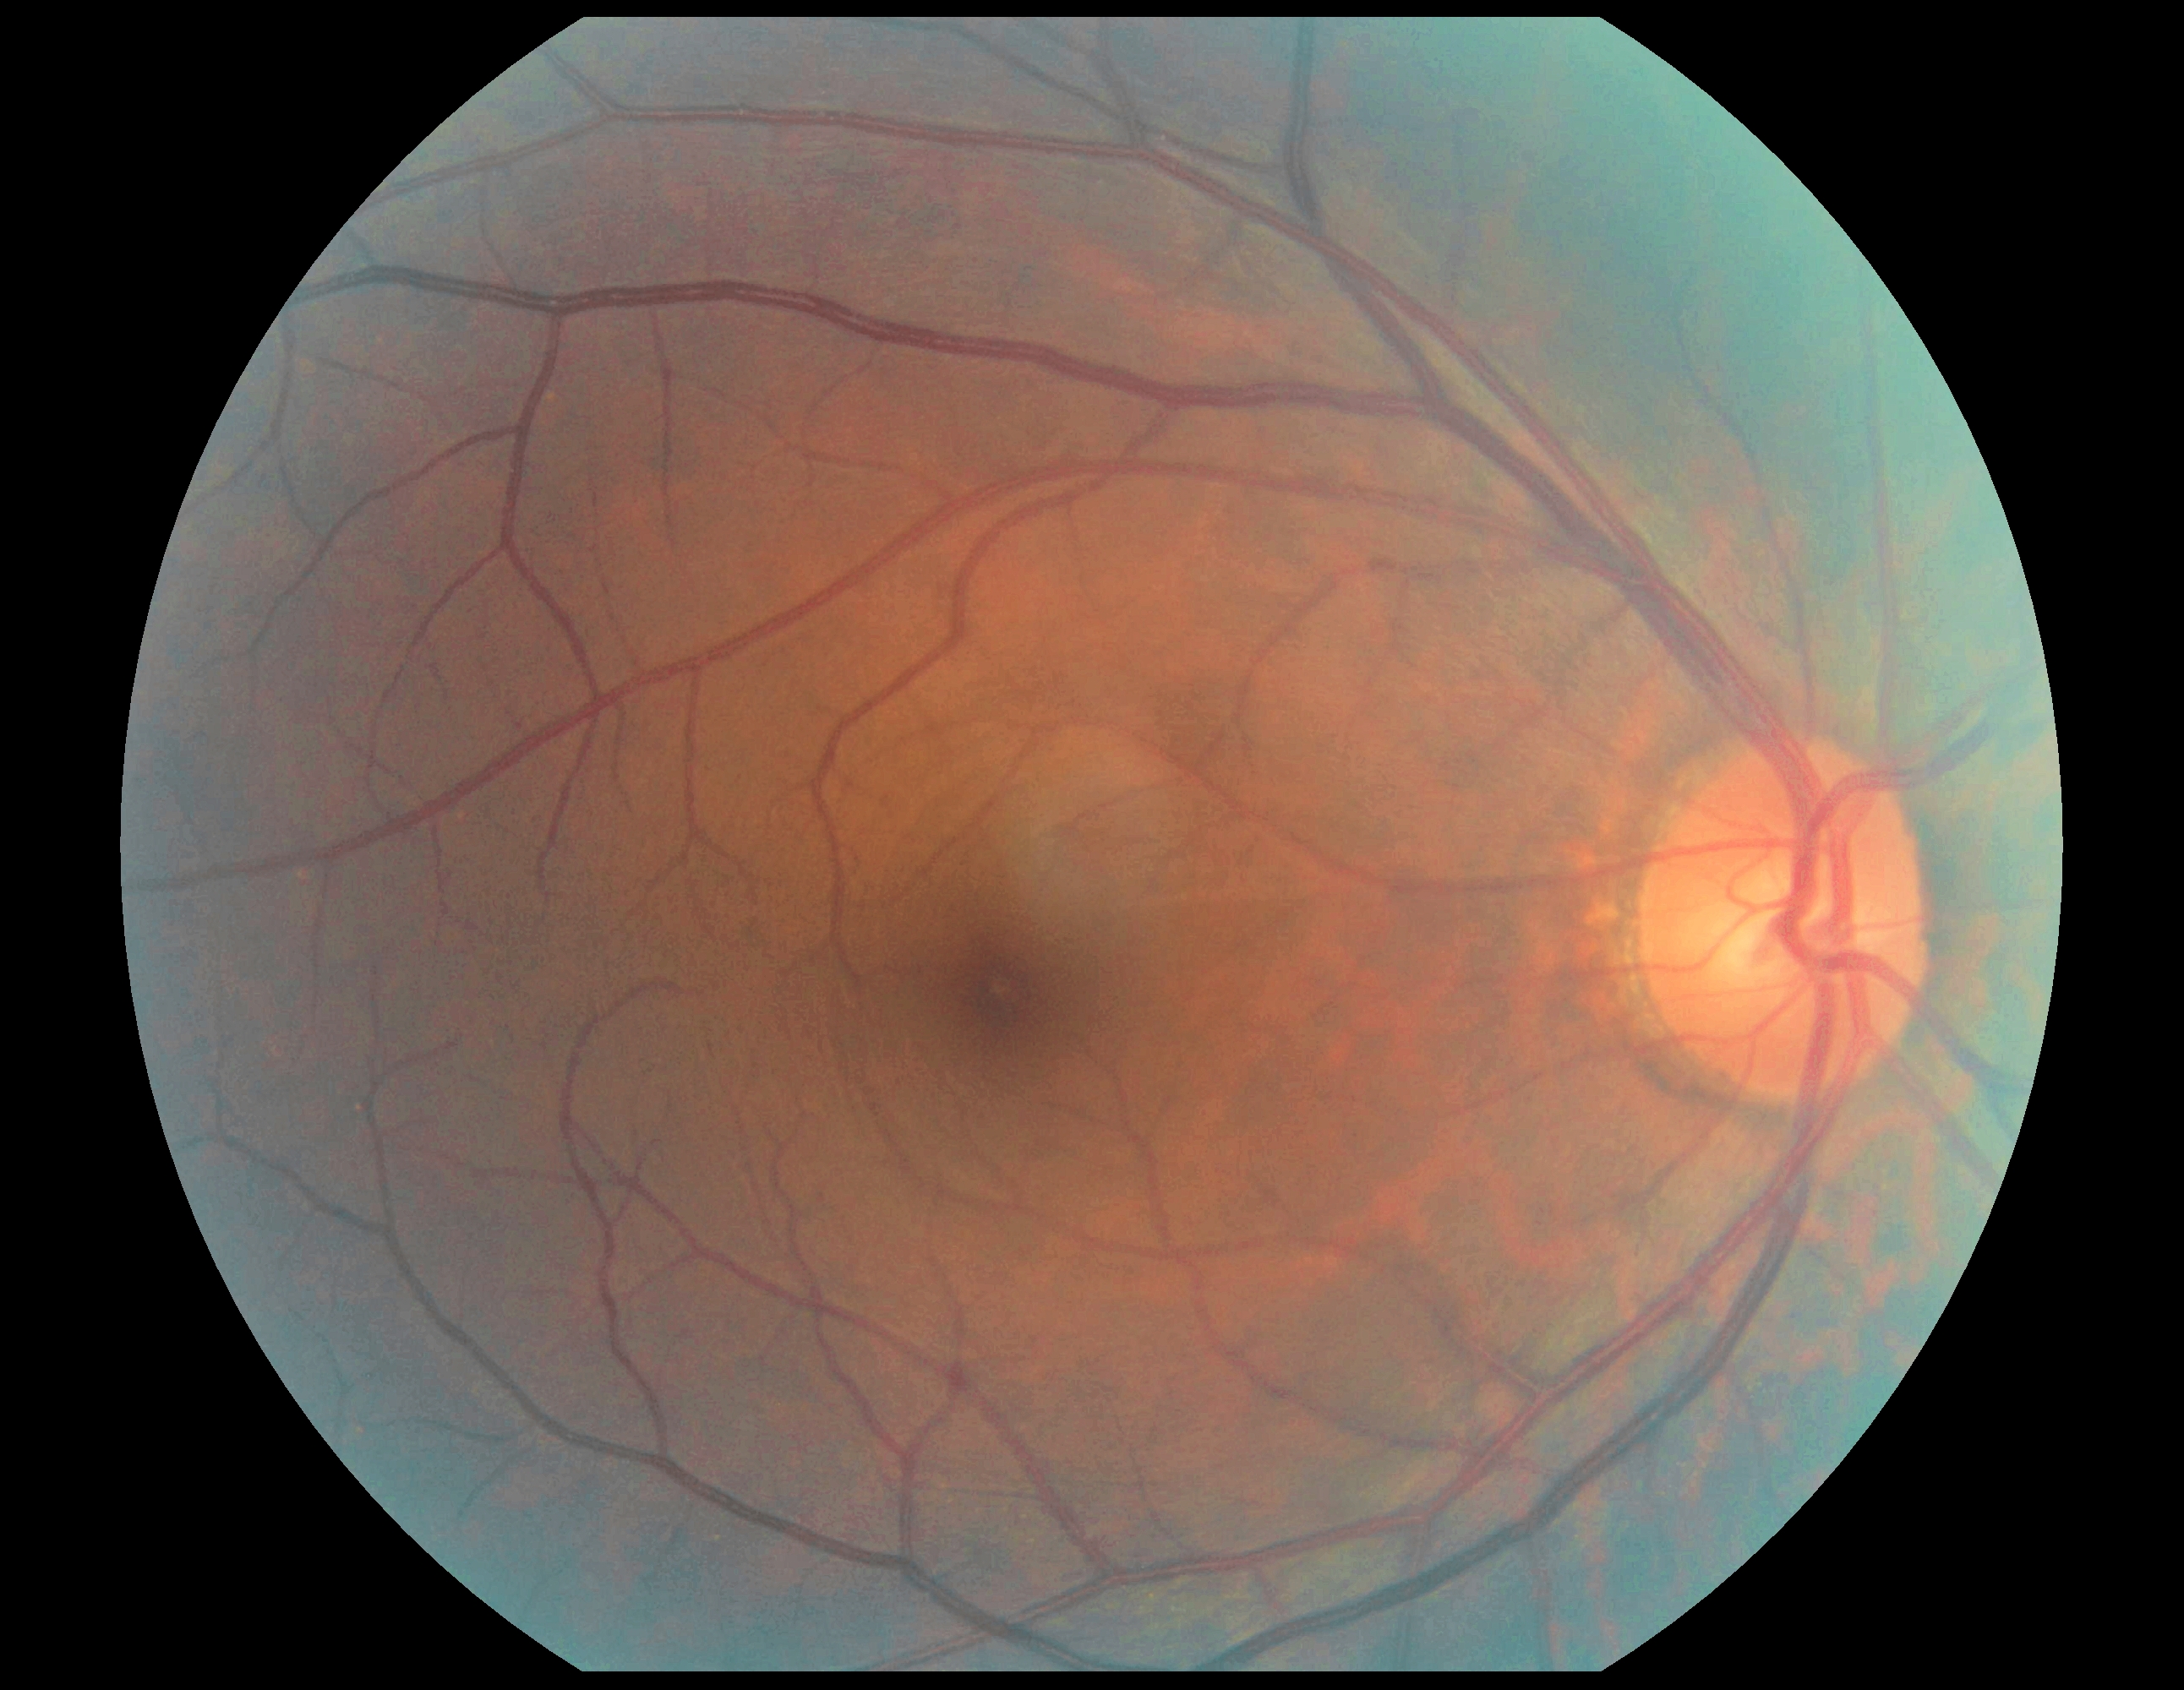 DR stage: 0.